512 x 512 pixels — 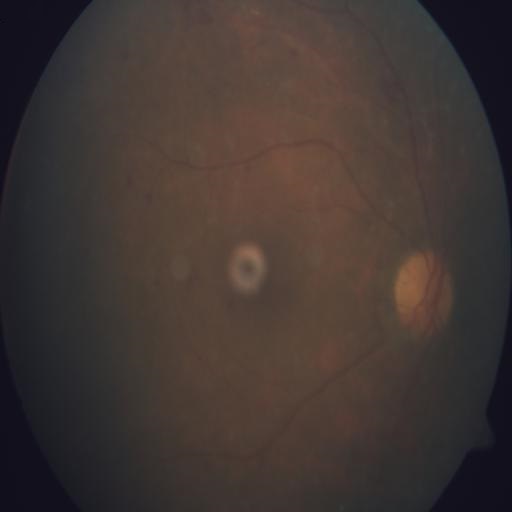
Findings consistent with optic disc pallor.